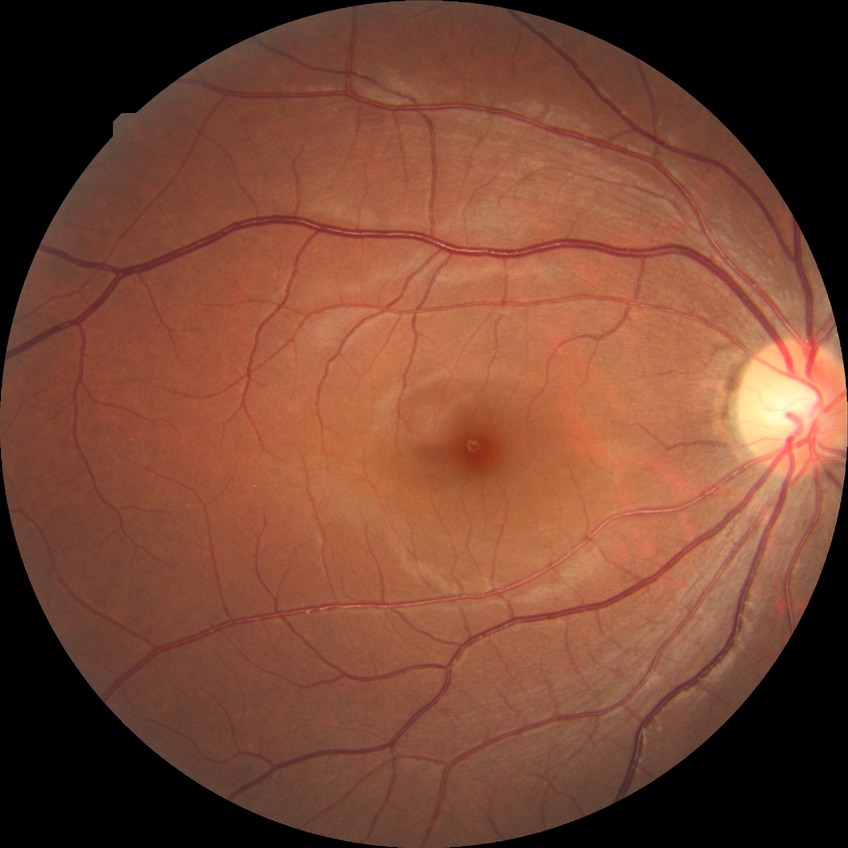

Diabetic retinopathy (DR): no diabetic retinopathy (NDR).